2212x1659px.
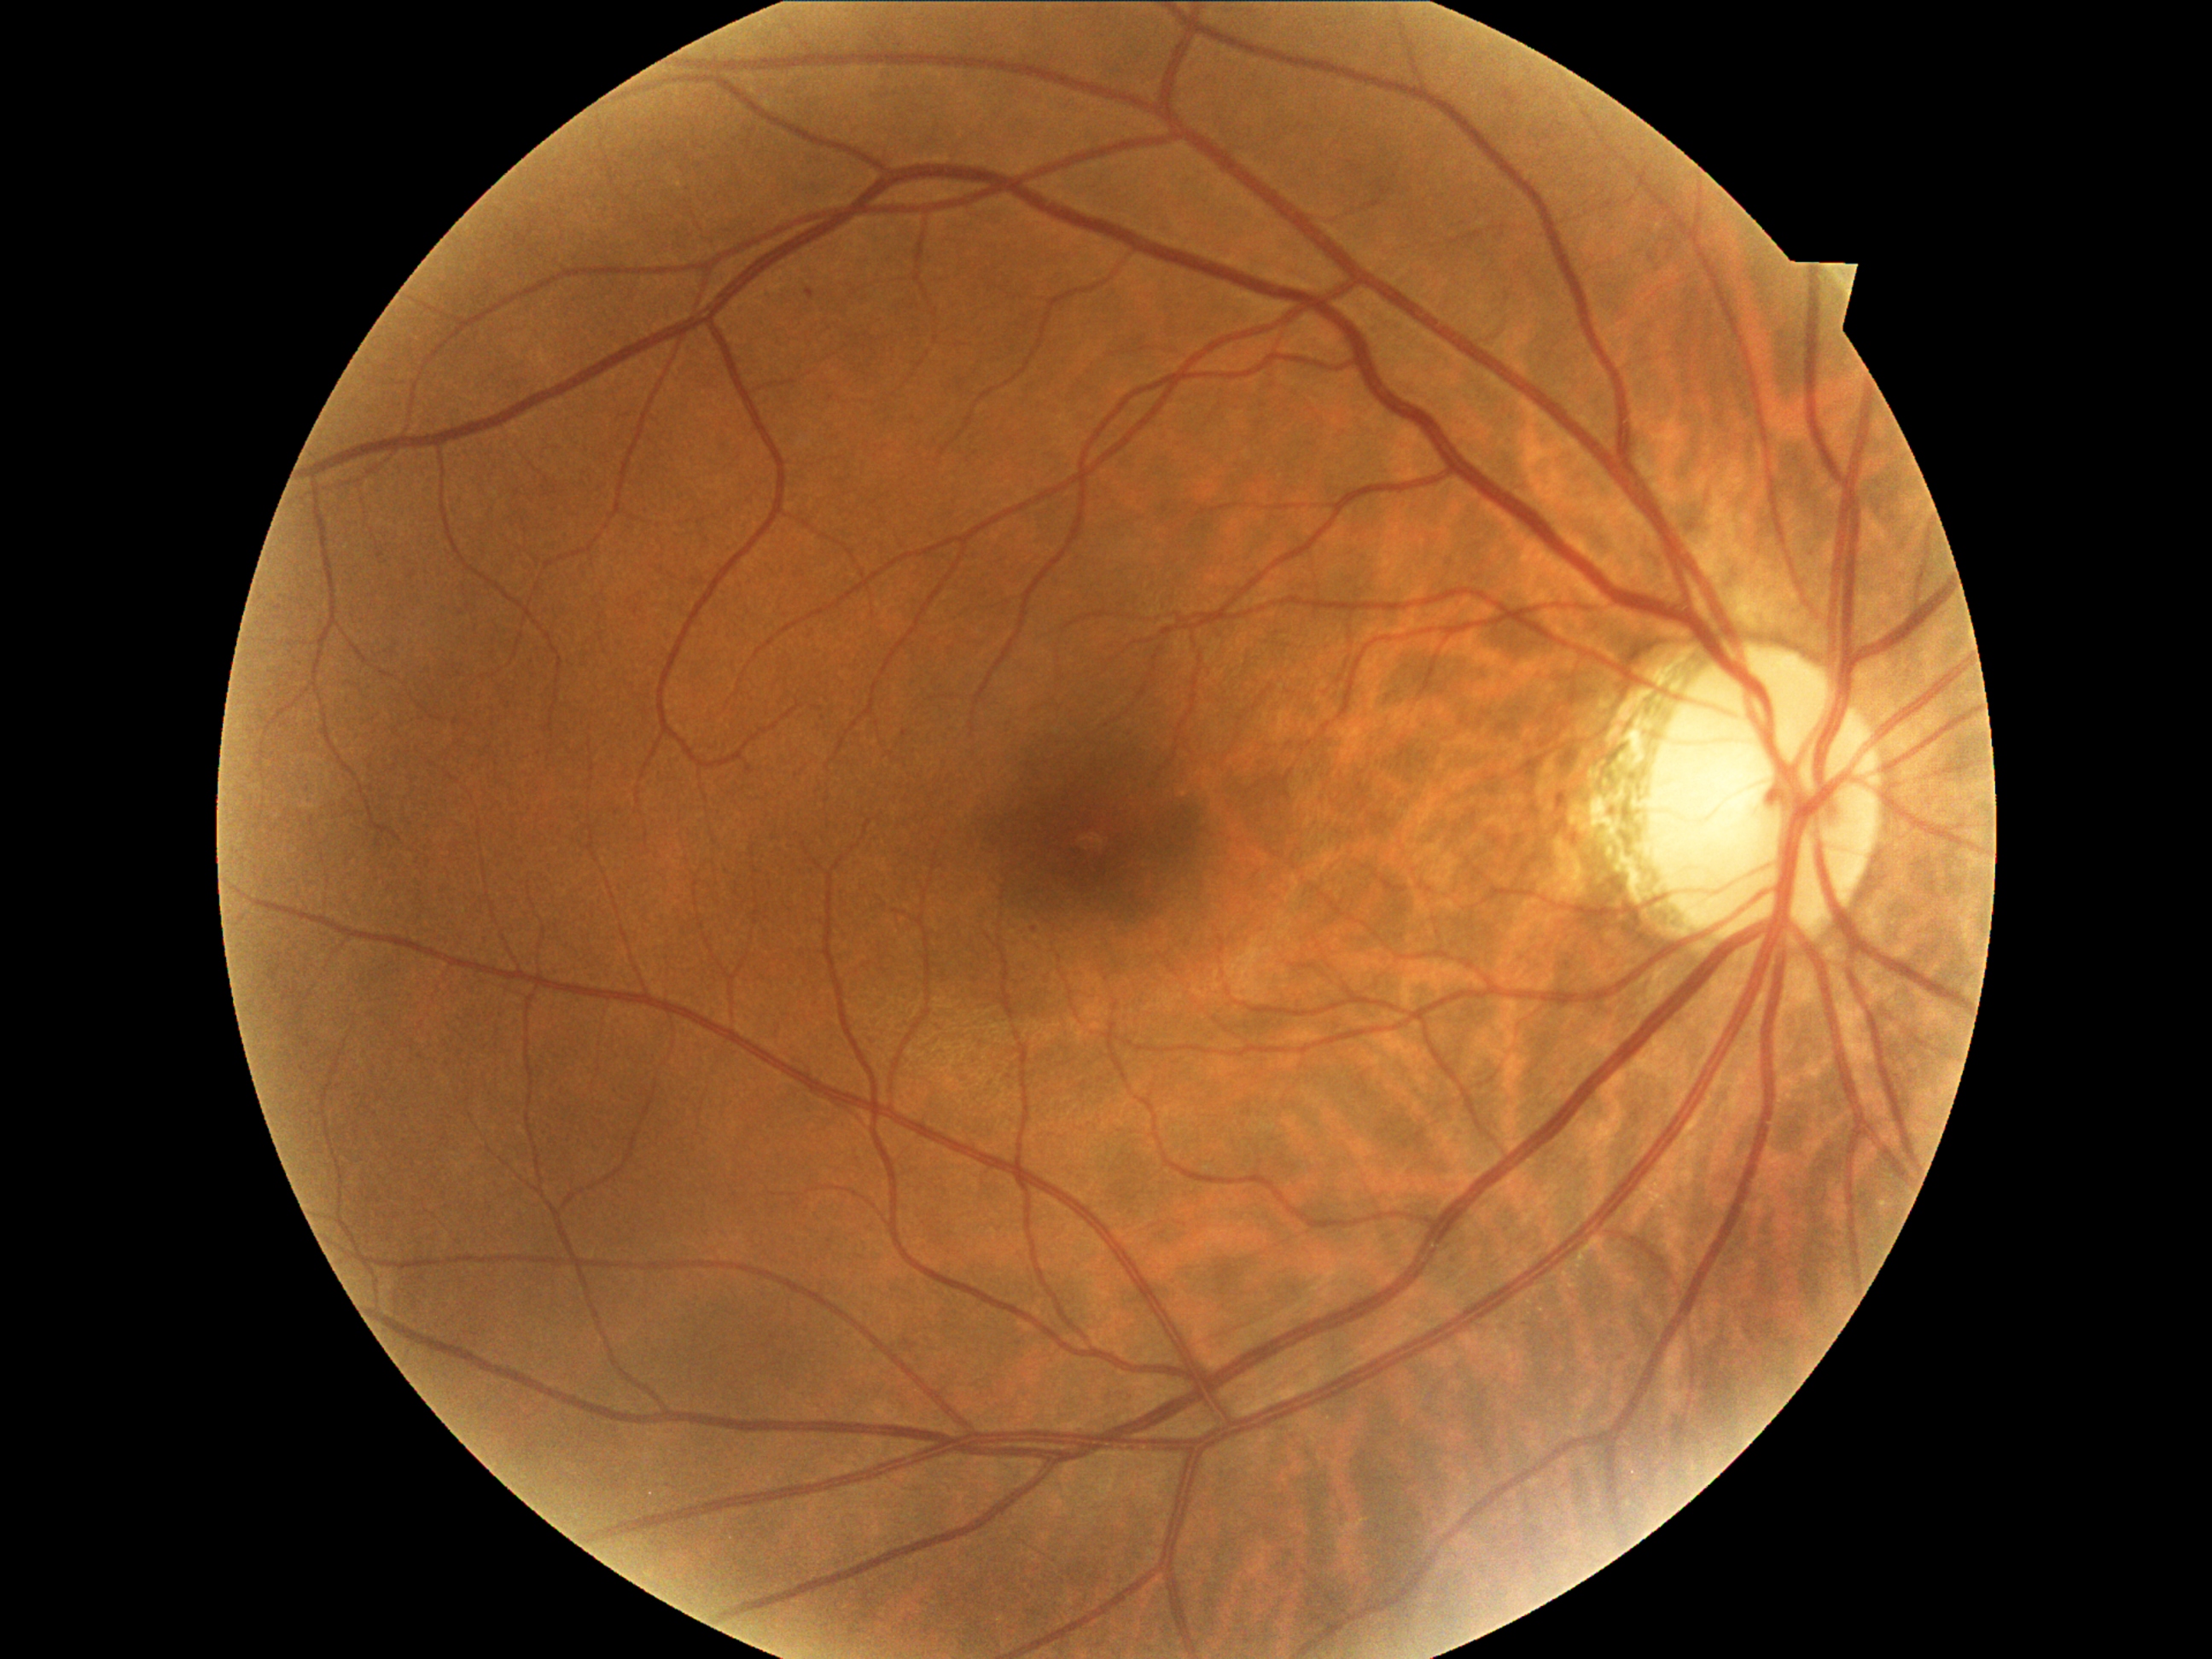 Annotations:
- retinopathy: 1